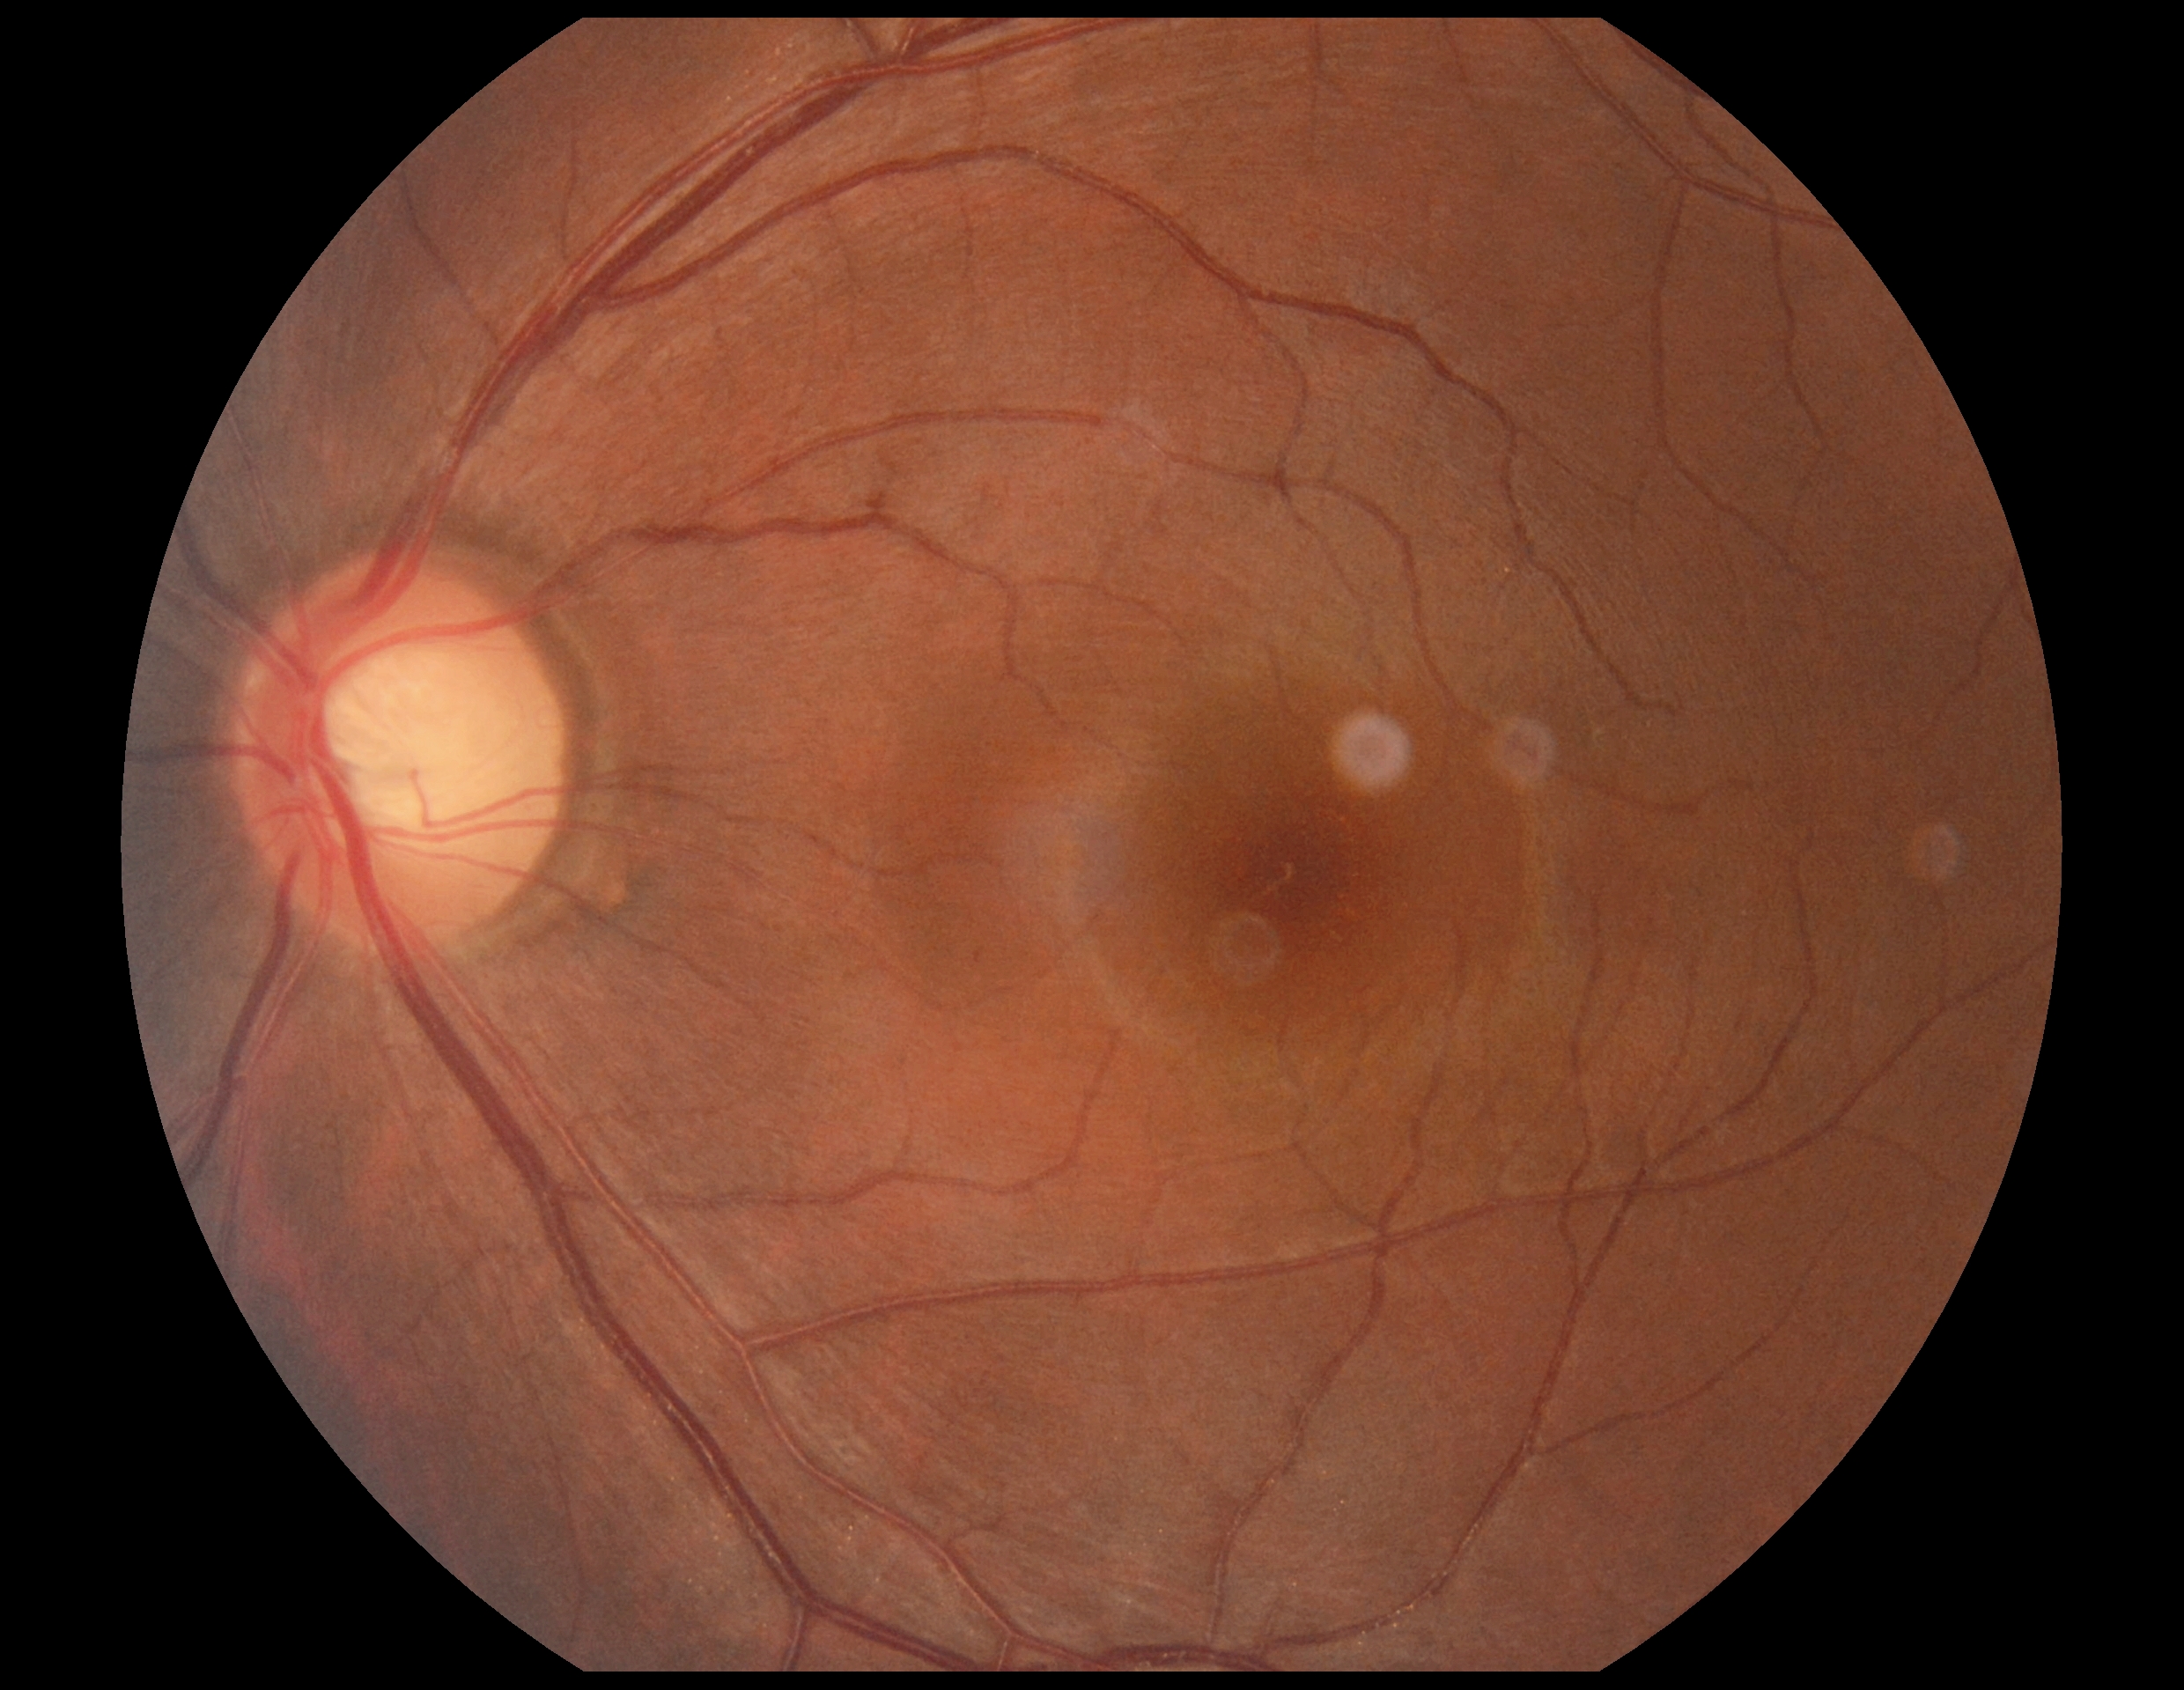

Retinopathy: 0/4.